FOV: 45 degrees: 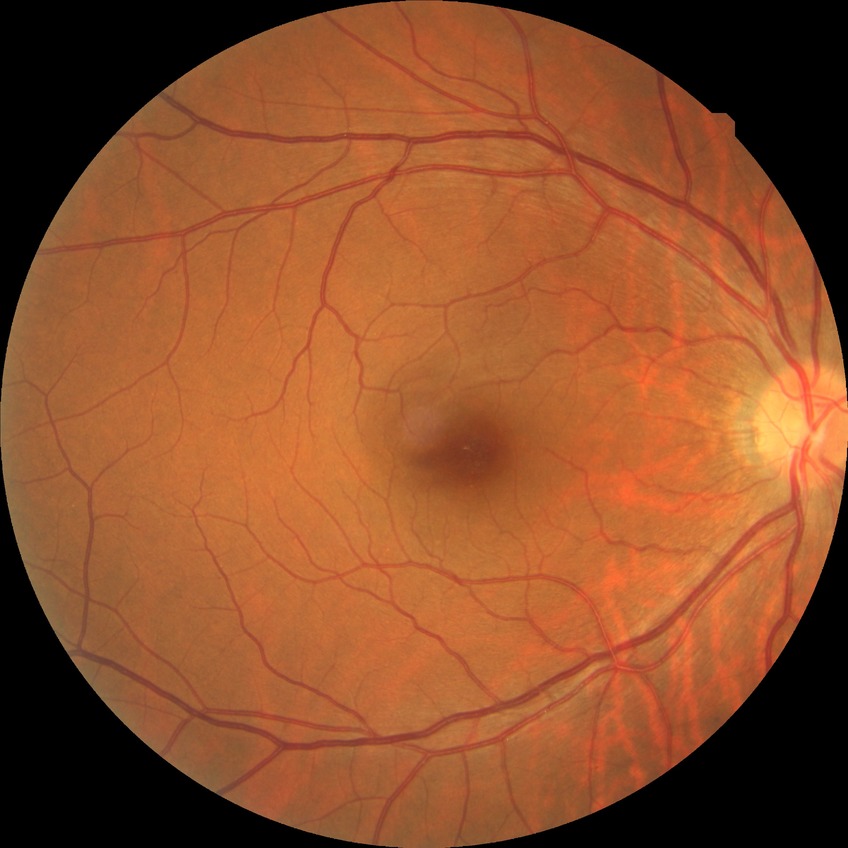
* diabetic retinopathy (DR): no diabetic retinopathy (NDR)